1659 x 2212 pixels. Camera: Remidio Fundus on Phone (FOP) camera.
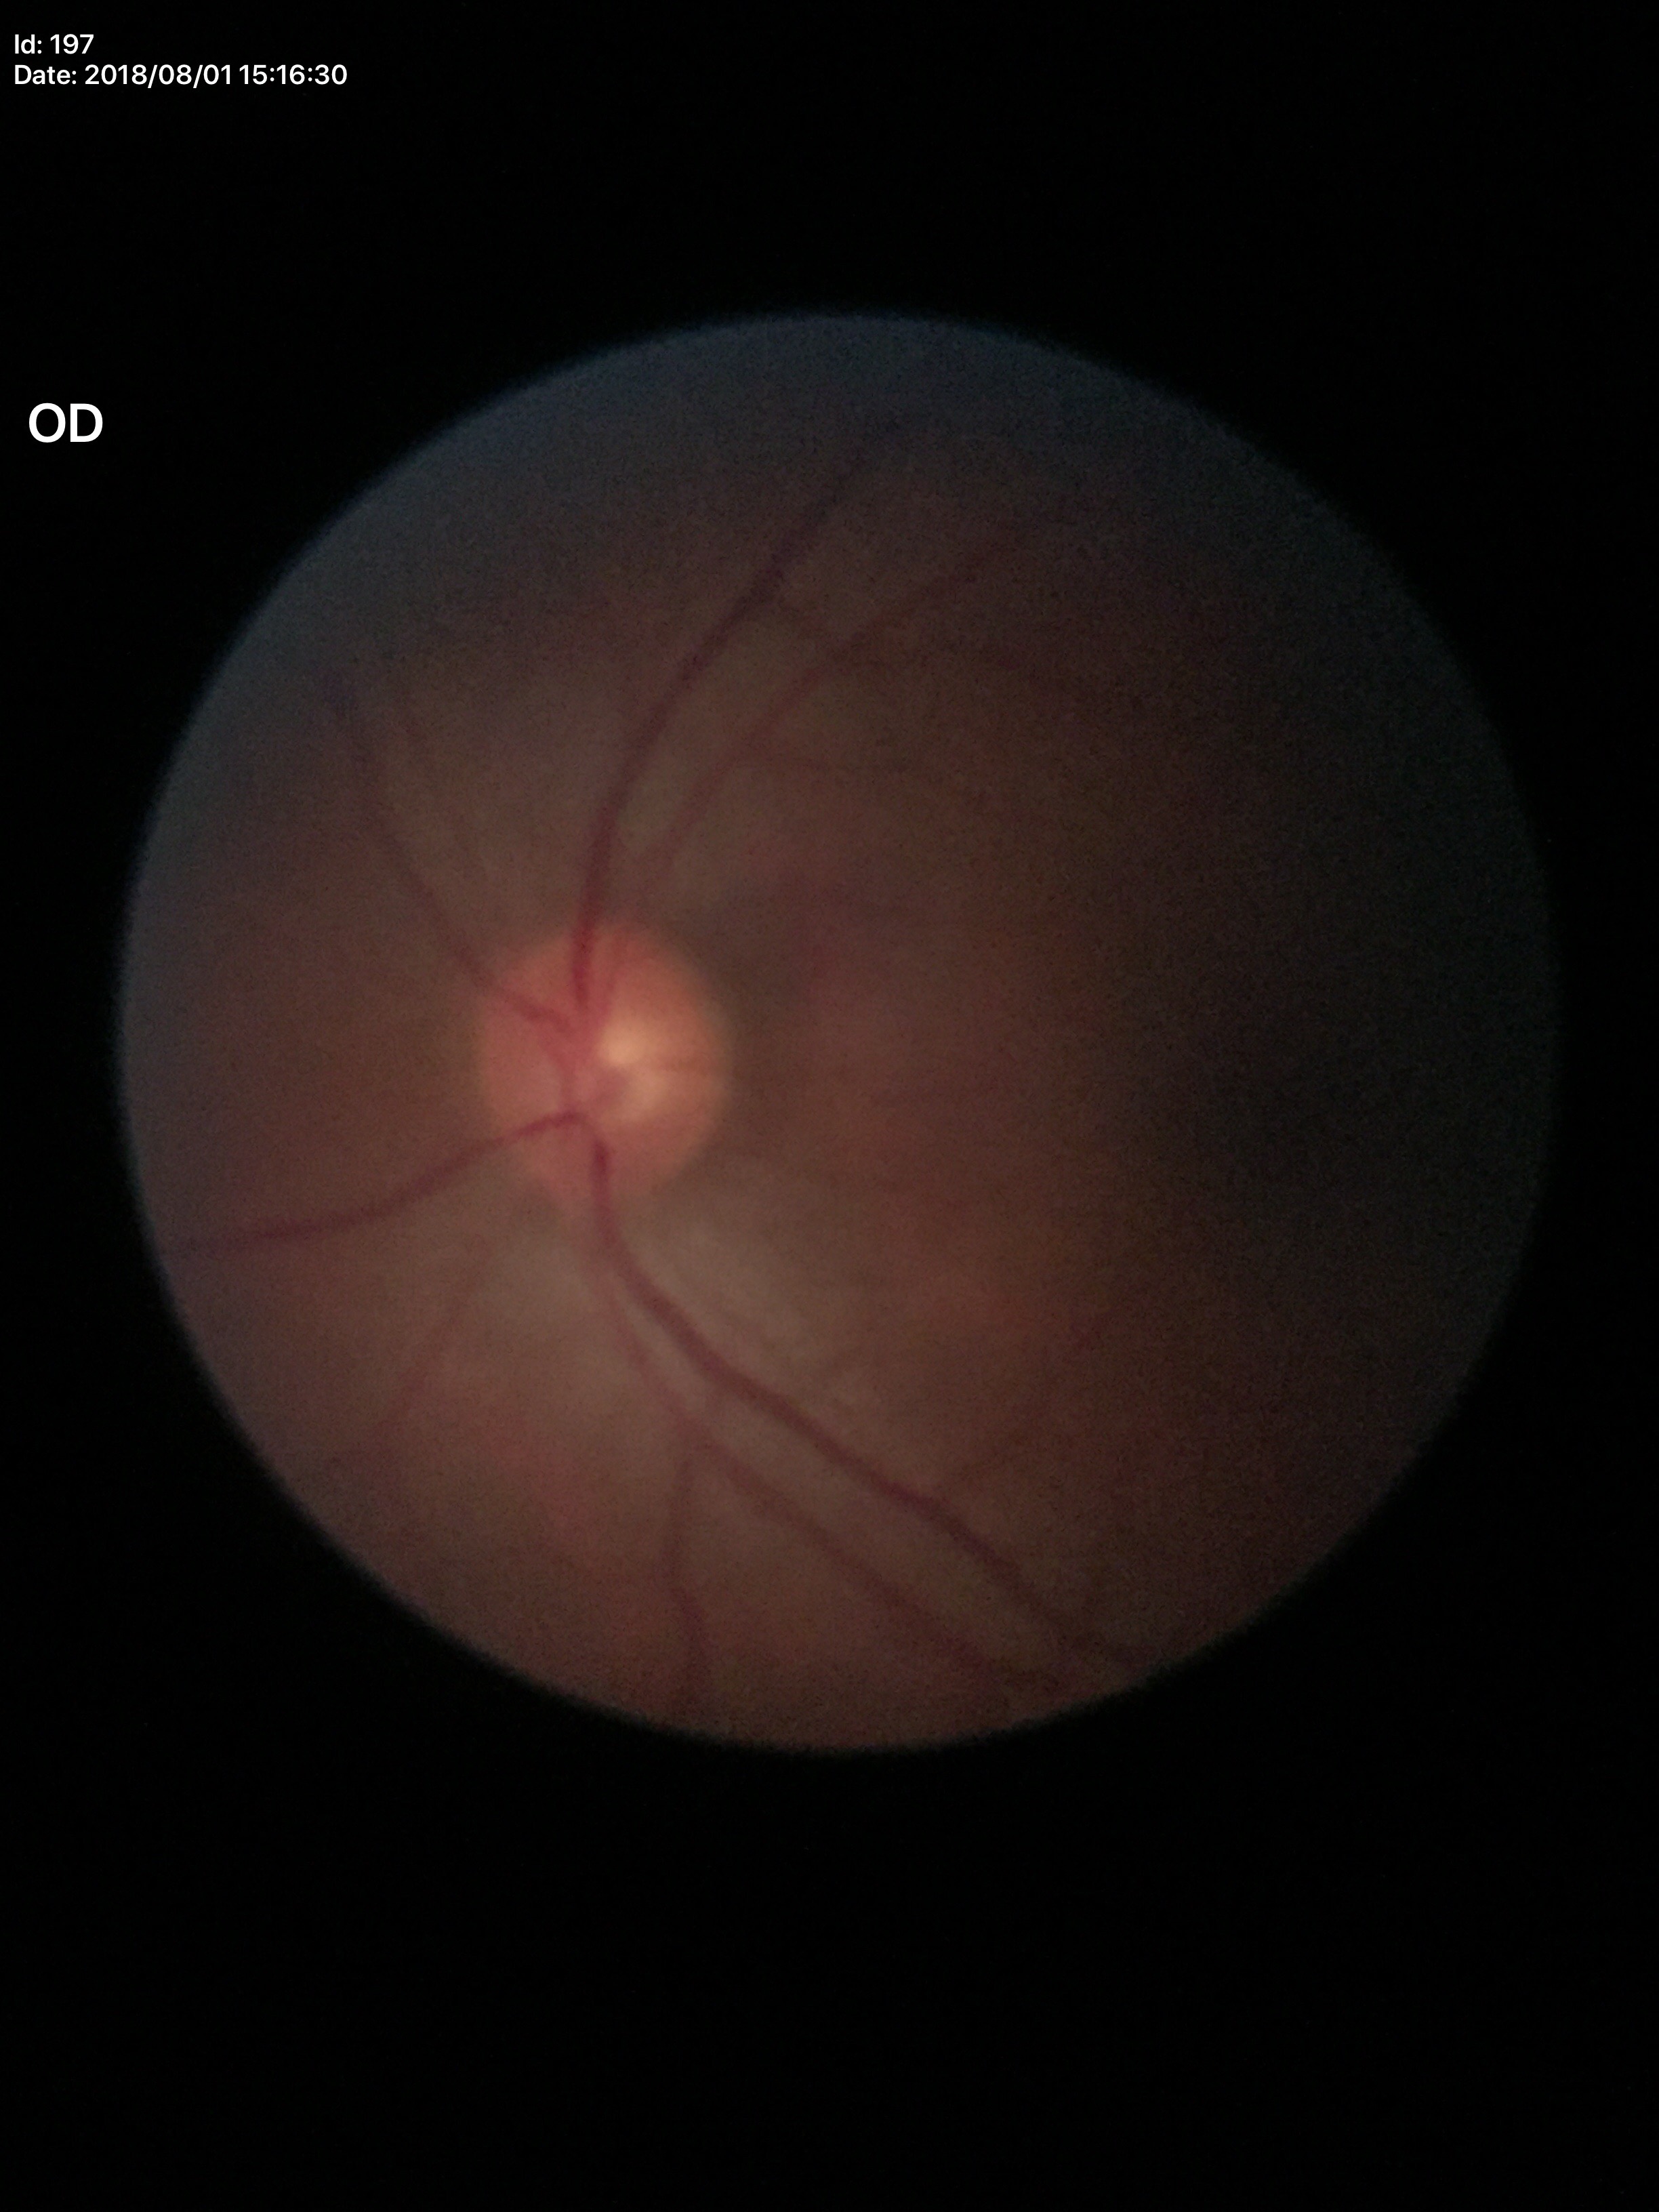
Glaucoma evaluation: not suspect.
VCDR of 0.51.